Color fundus image — 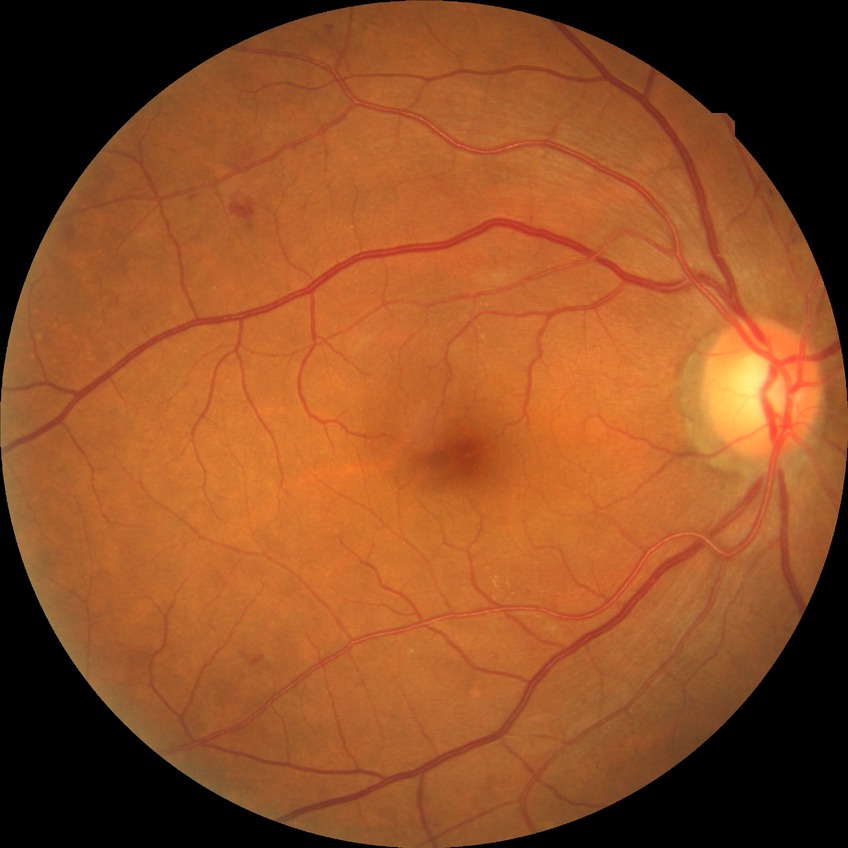
Davis grading: simple diabetic retinopathy.